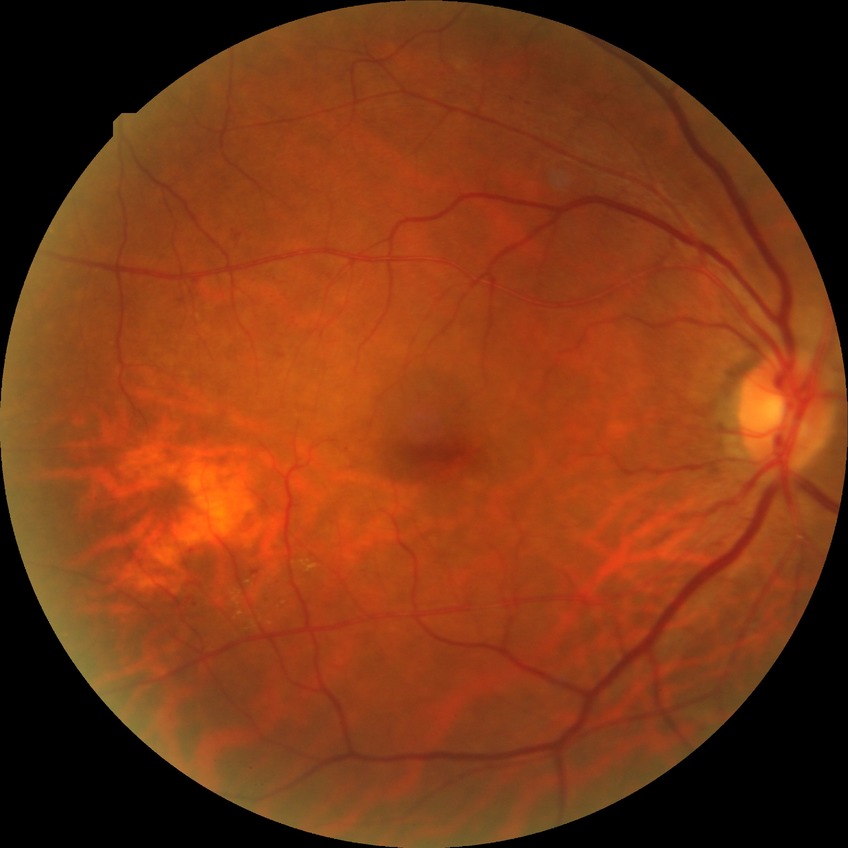
* Davis DR grade — SDR